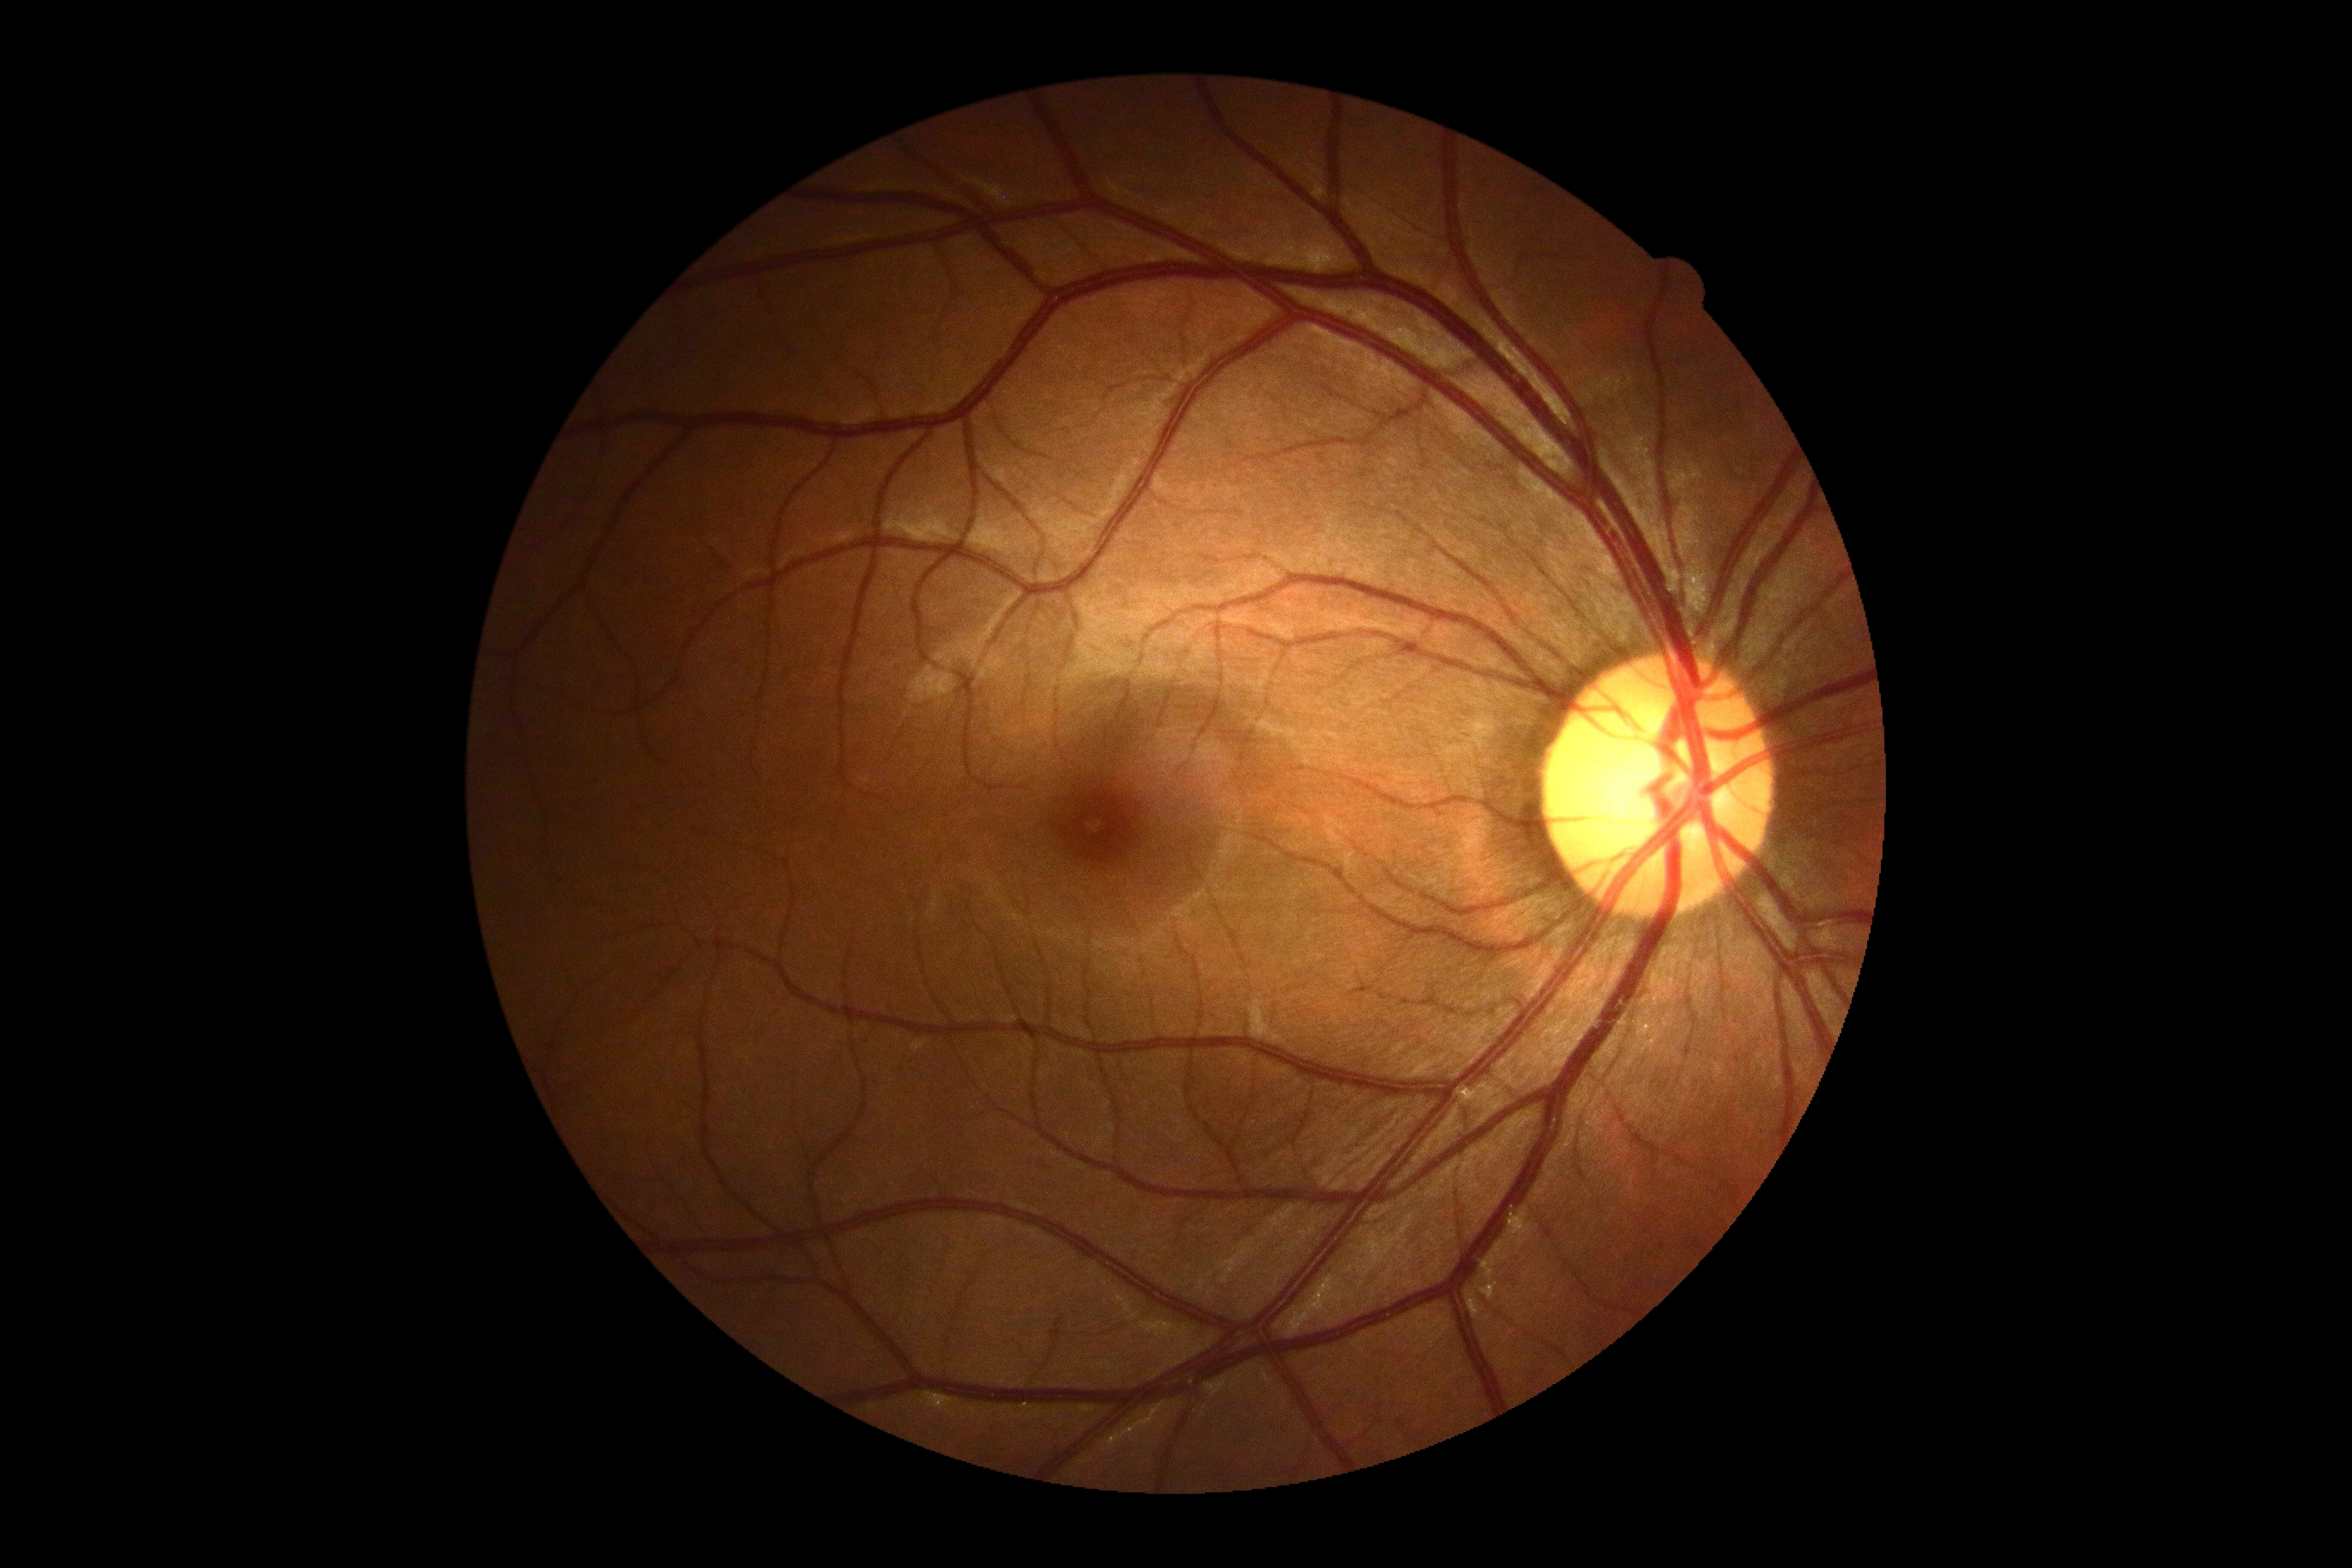
diabetic retinopathy (DR) = no apparent diabetic retinopathy (grade 0) | DR impression = negative for DR.